Image size 2352x1568
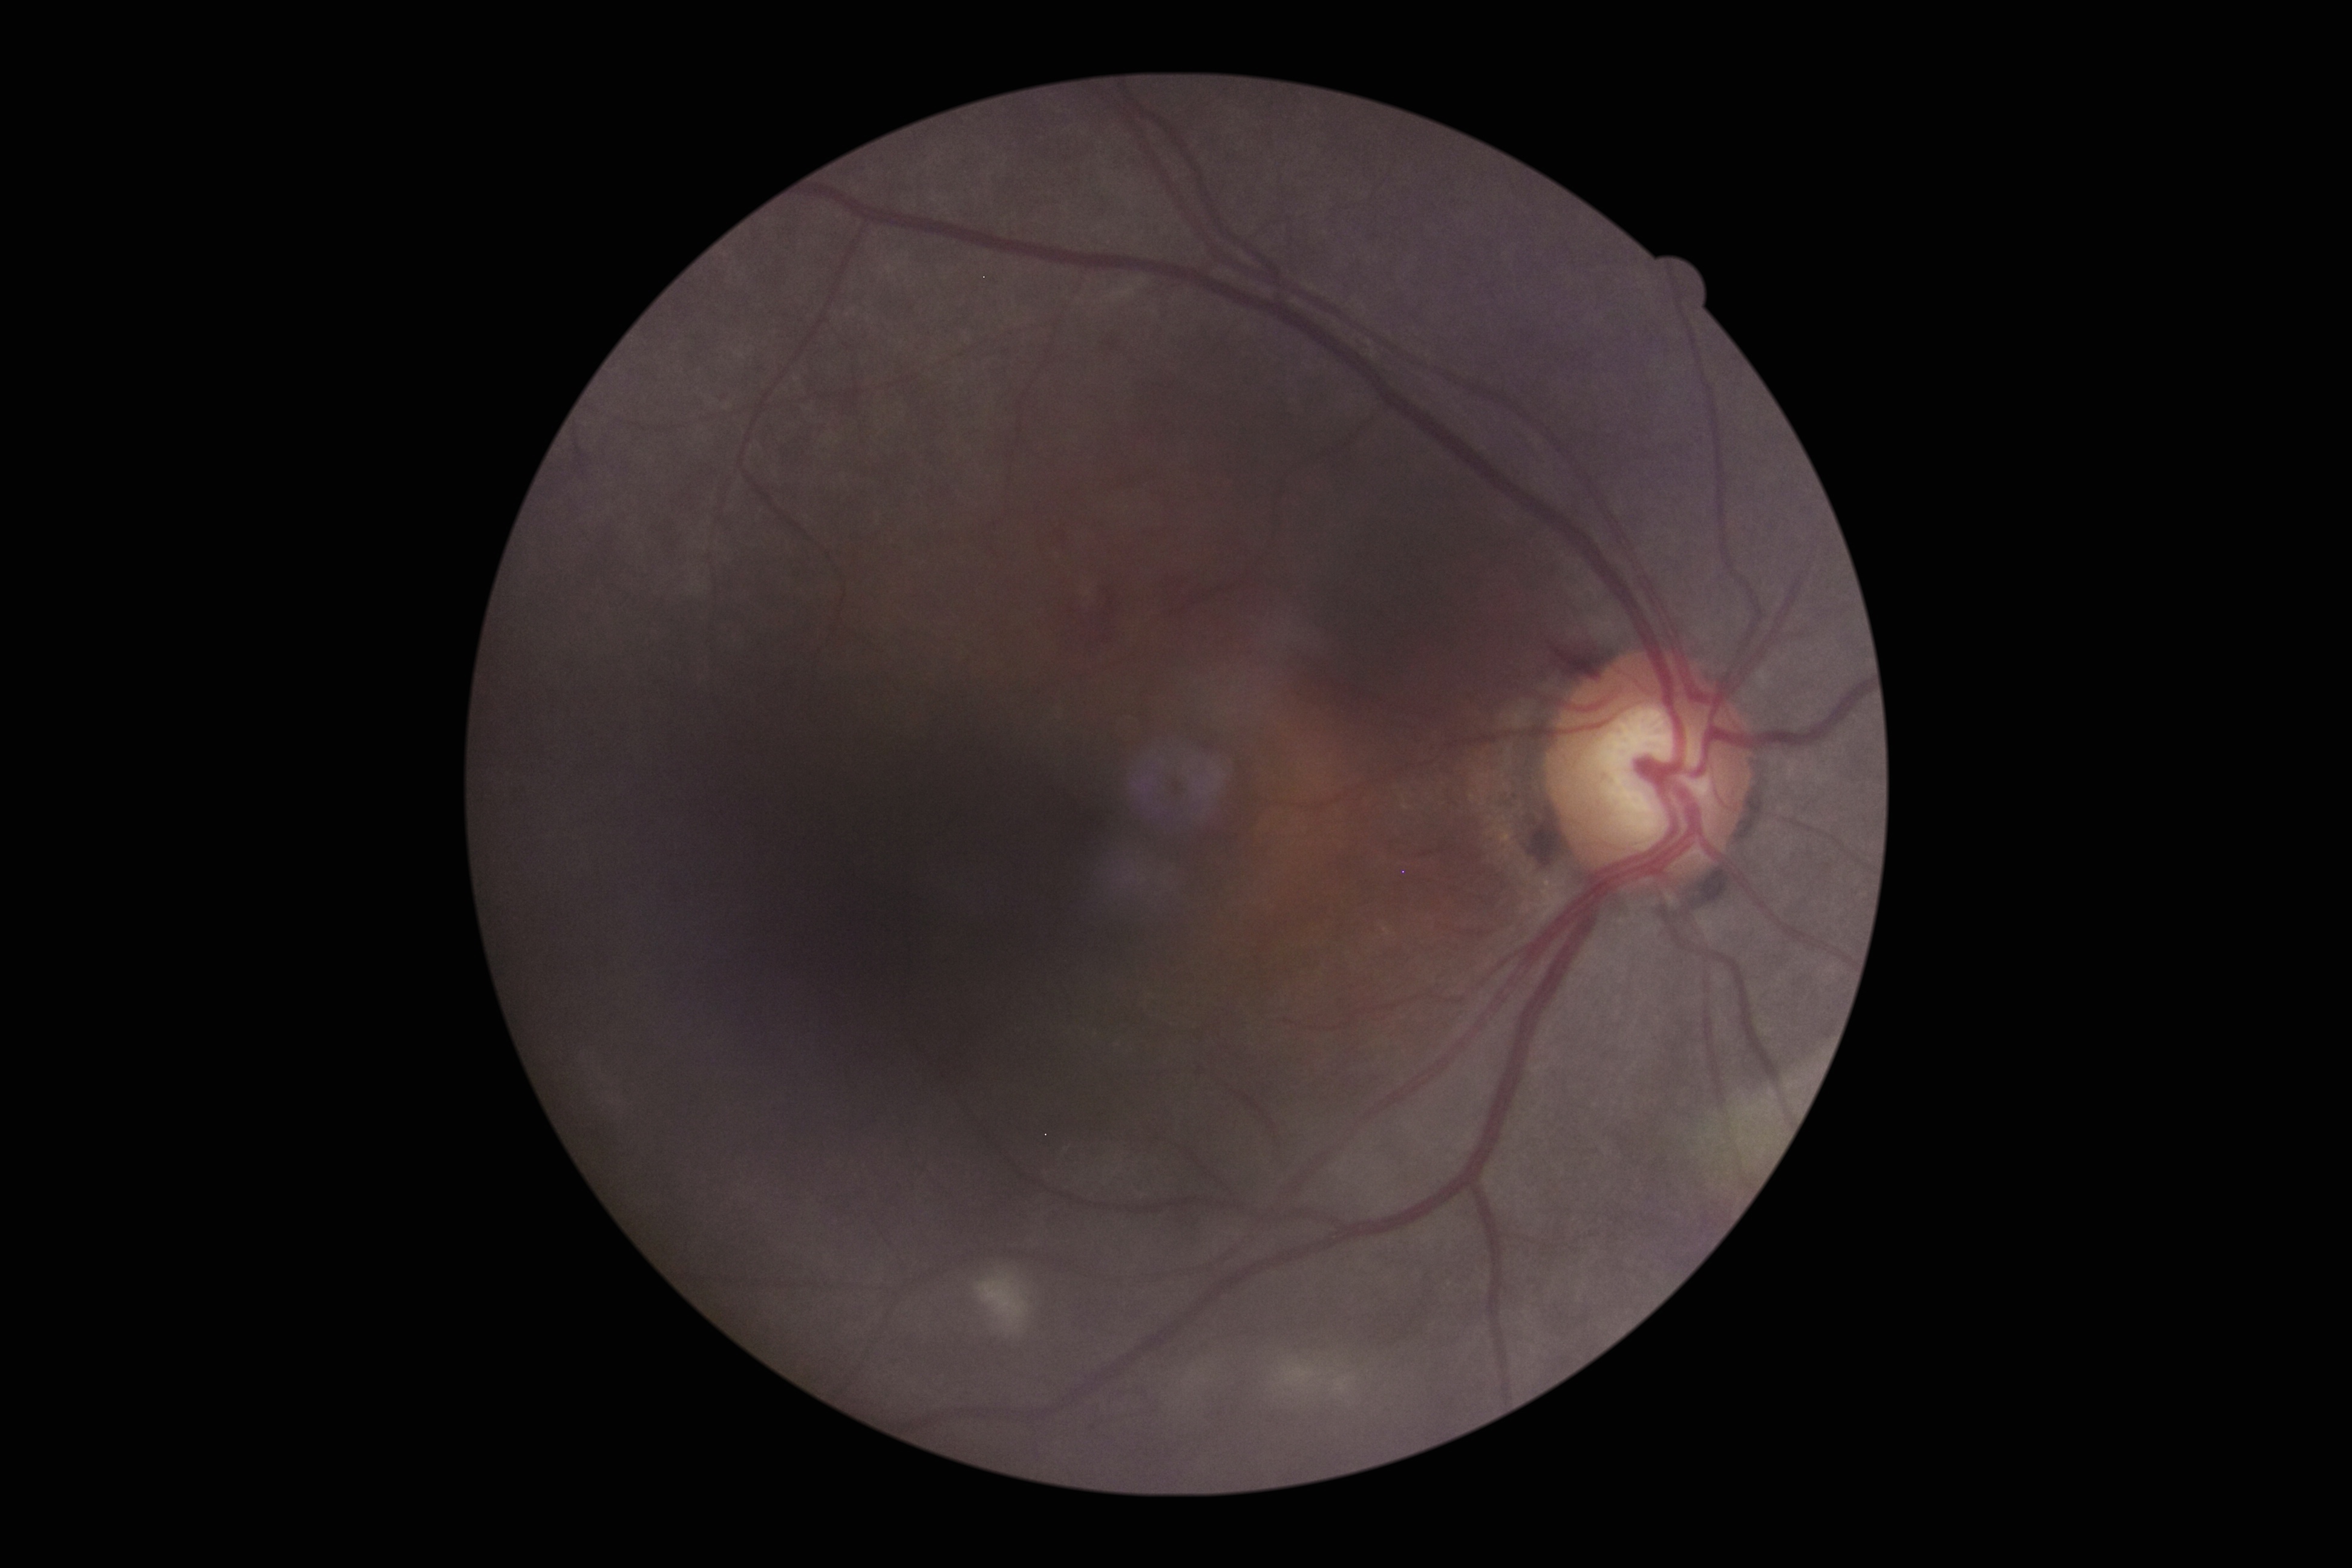
diabetic retinopathy (DR)@grade 2 (moderate NPDR).